Centered on the macula · pupil-dilated
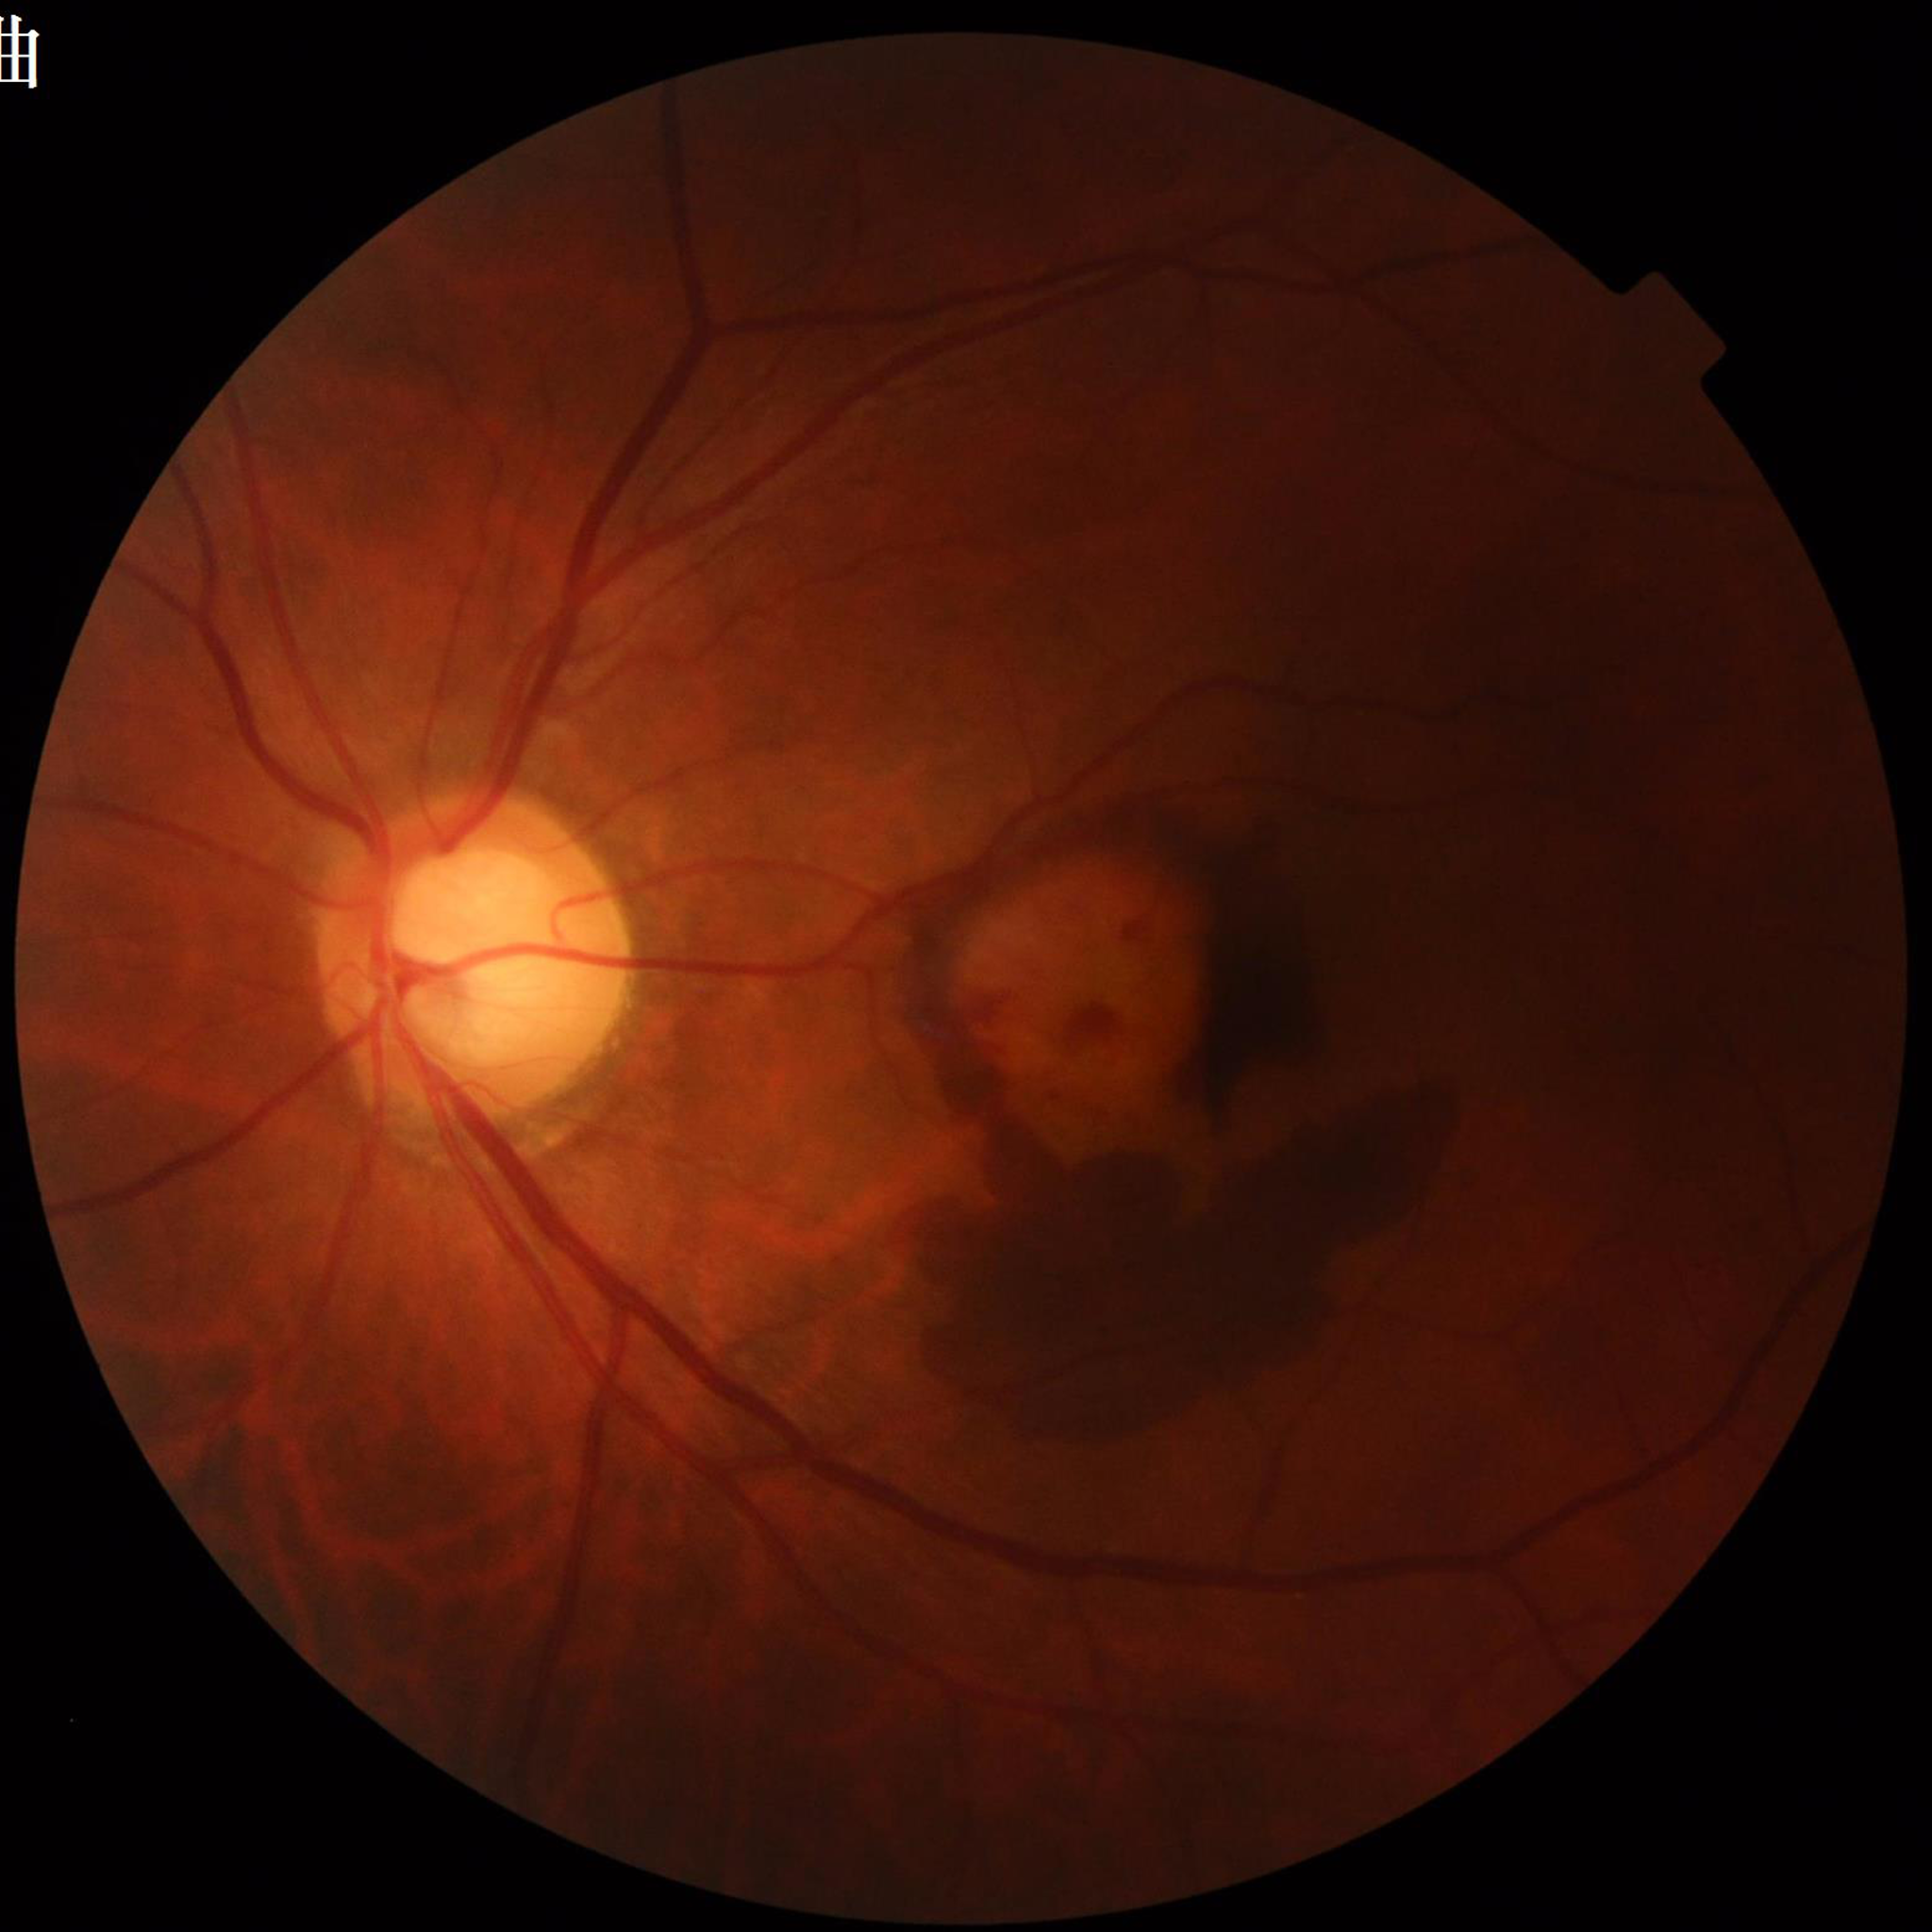

From a patient with AMD. Image quality: reduced — illumination/color distortion.